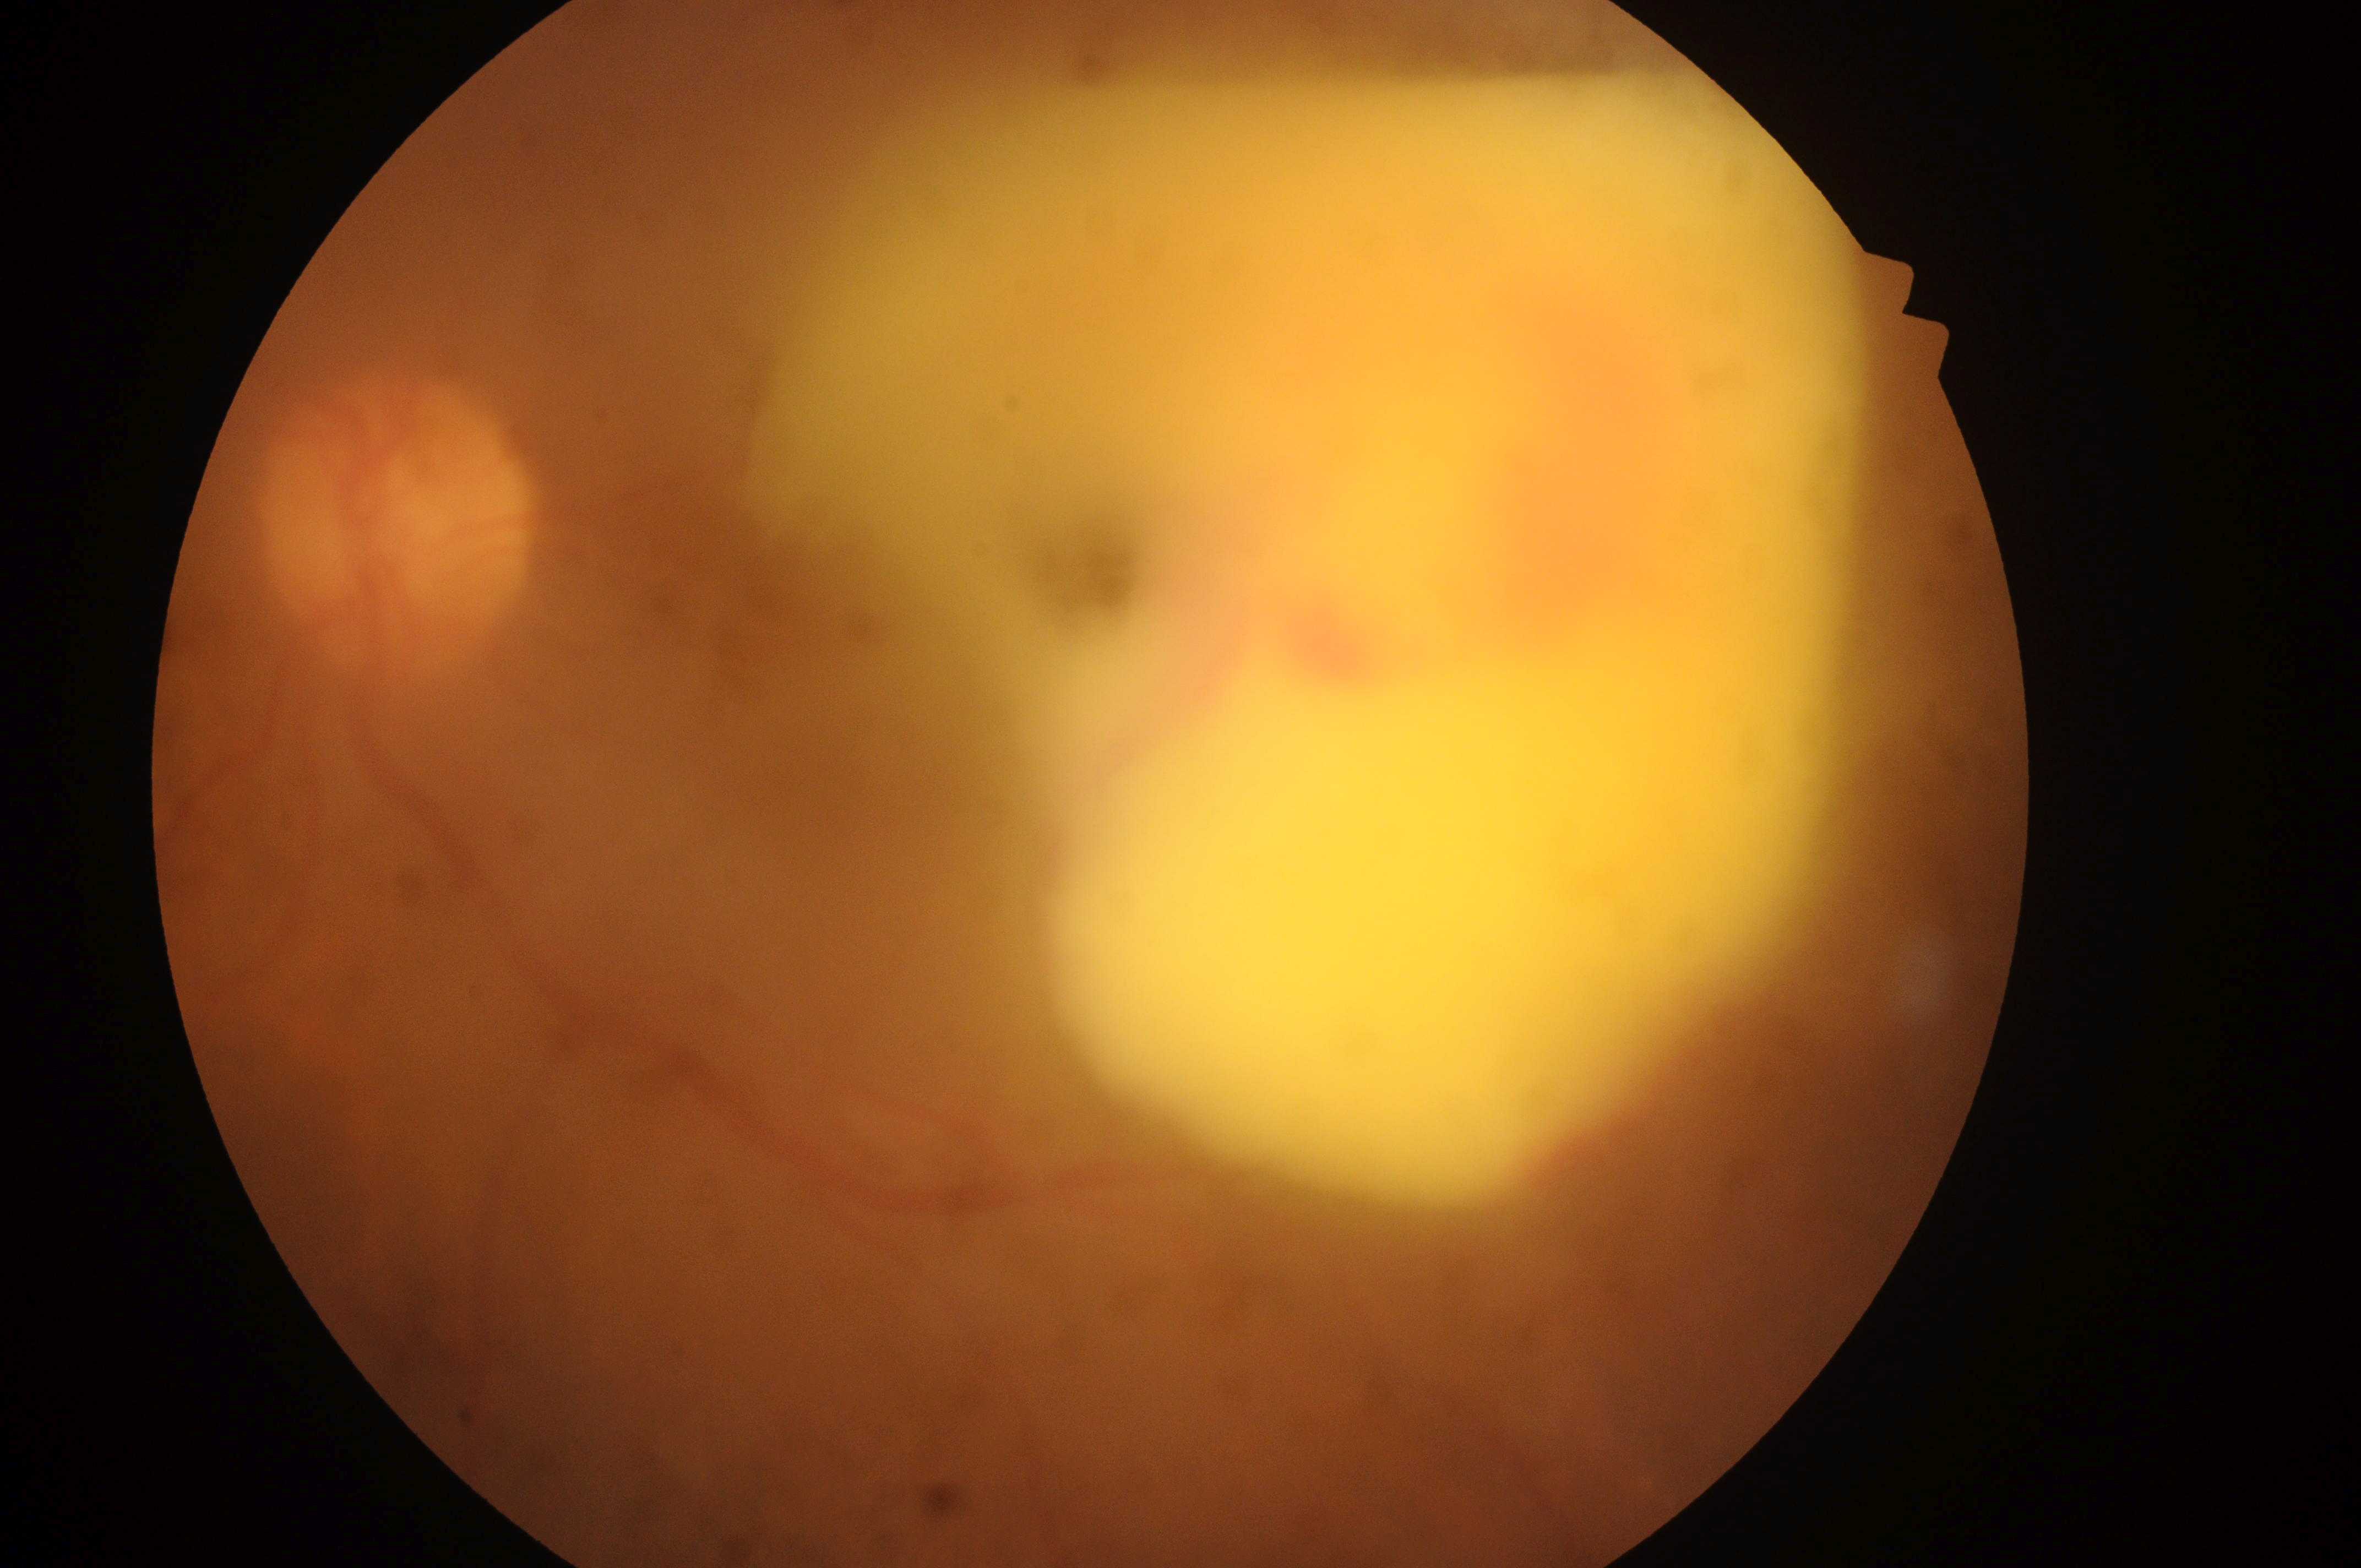

DME: high risk (grade 2)
foveal center: [1188, 391]
laterality: oculus sinister
DR stage: grade 4 (PDR)
optic nerve head: [391, 530]
DR class: proliferative diabetic retinopathy